Retinal fundus photograph — 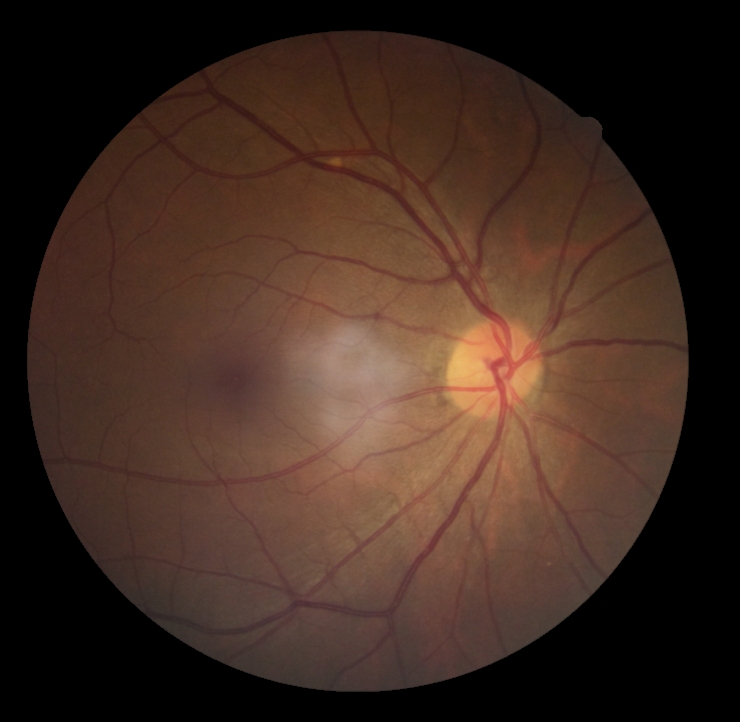
DR = no apparent diabetic retinopathy (grade 0) — no visible signs of diabetic retinopathy